CFP — 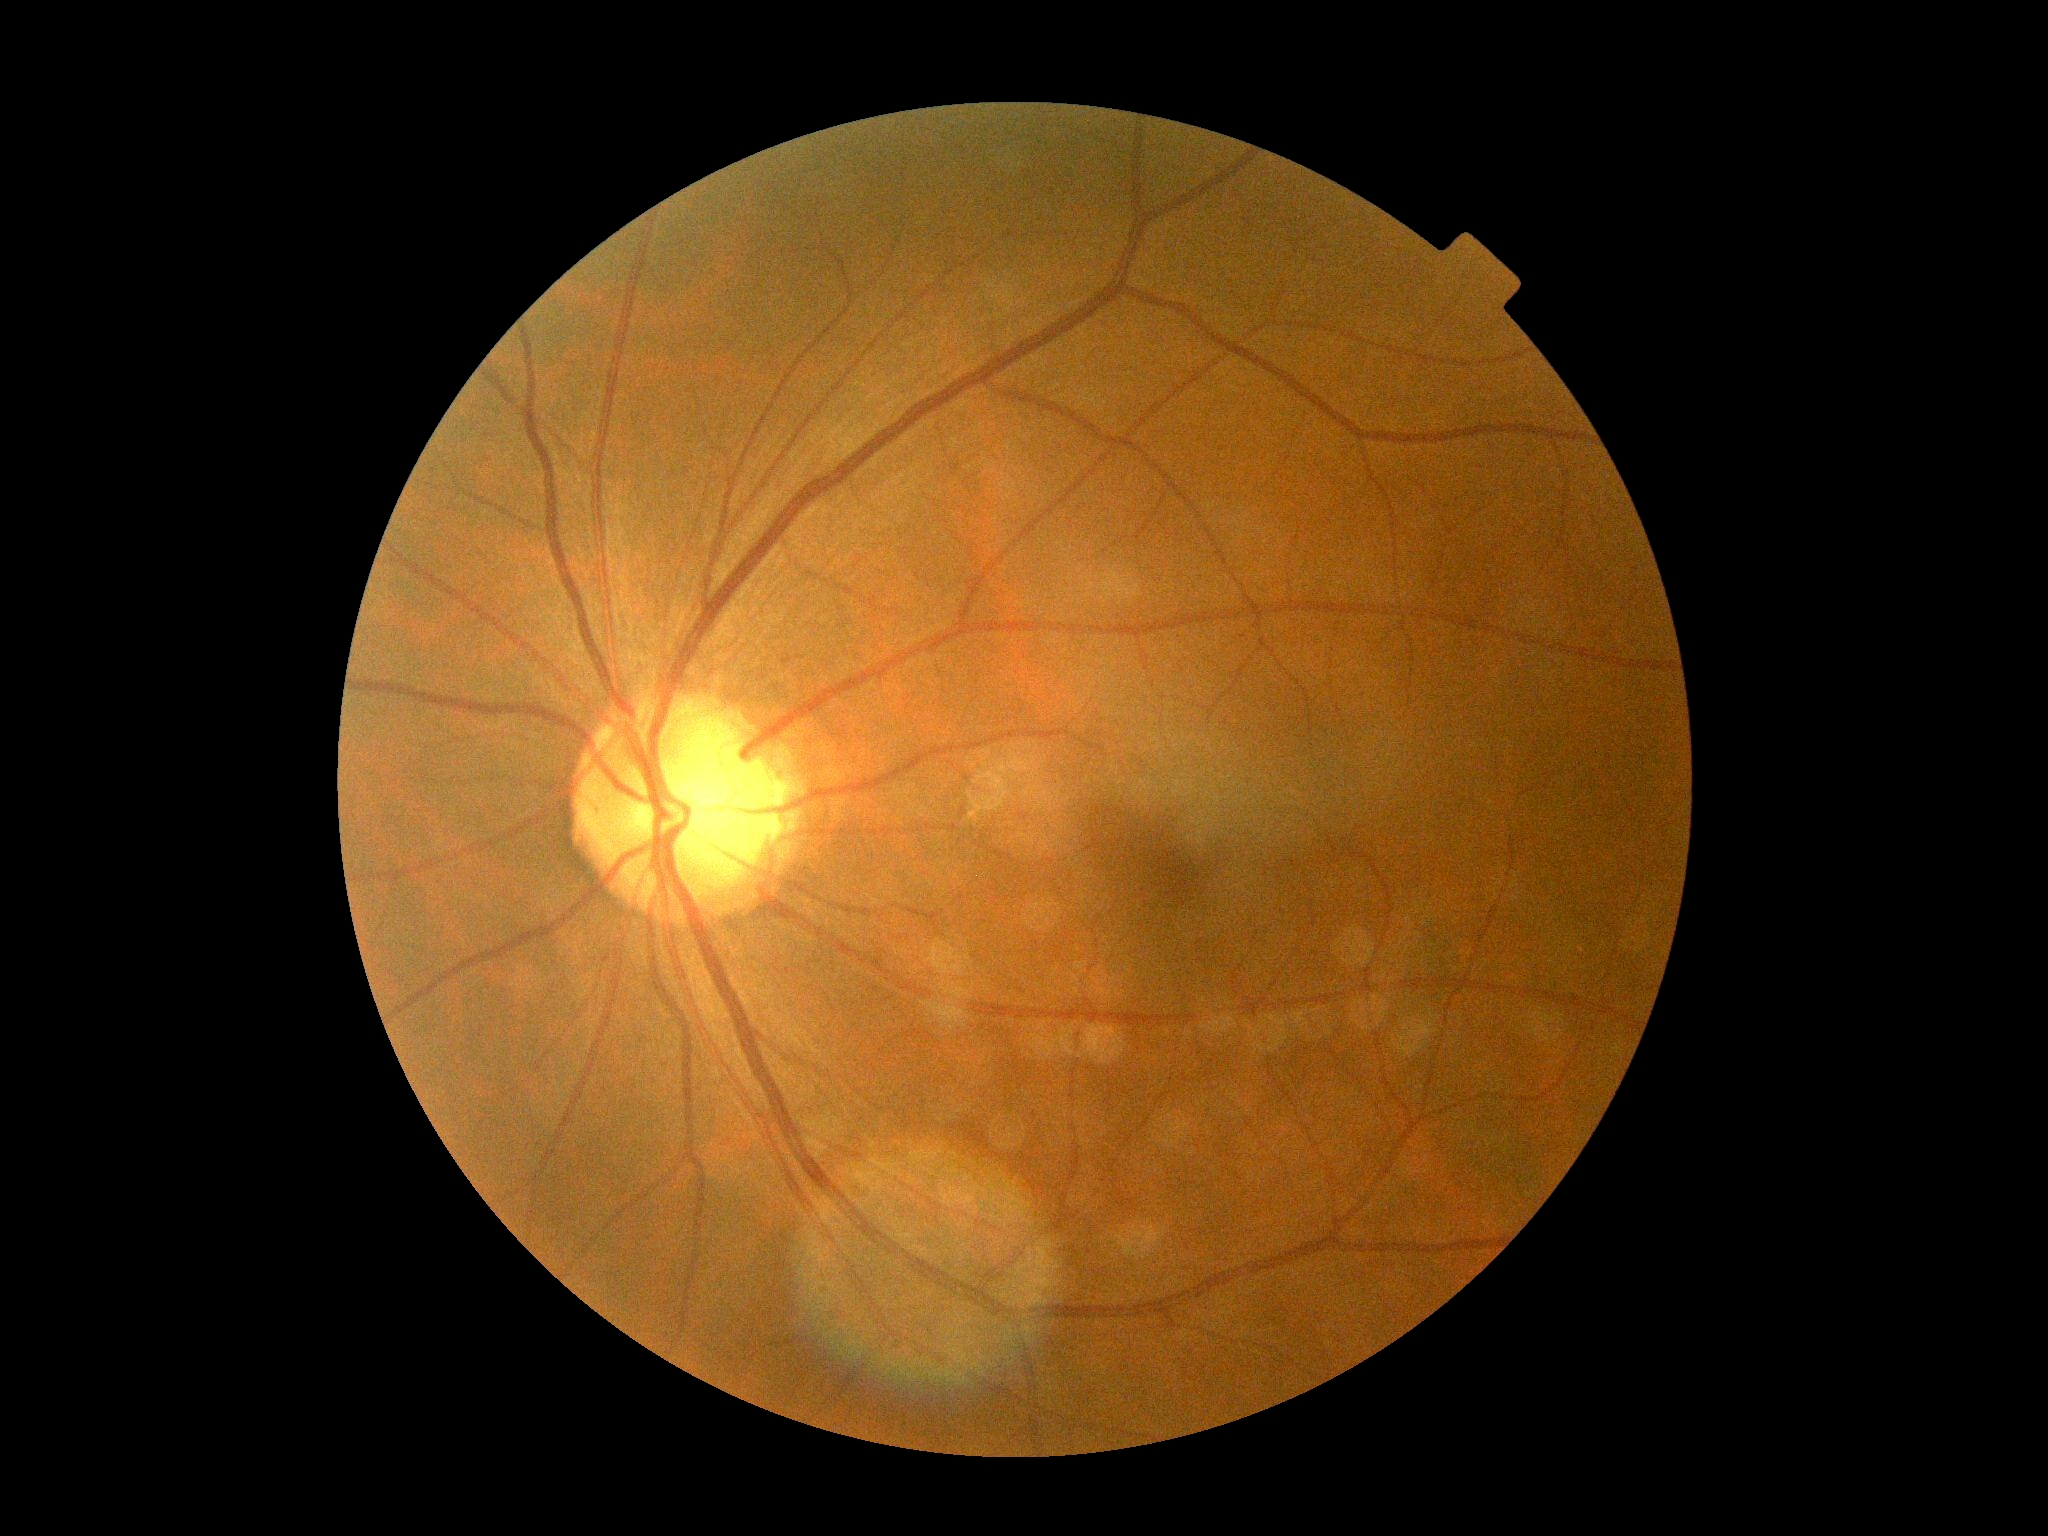
DR stage: no apparent retinopathy (grade 0).